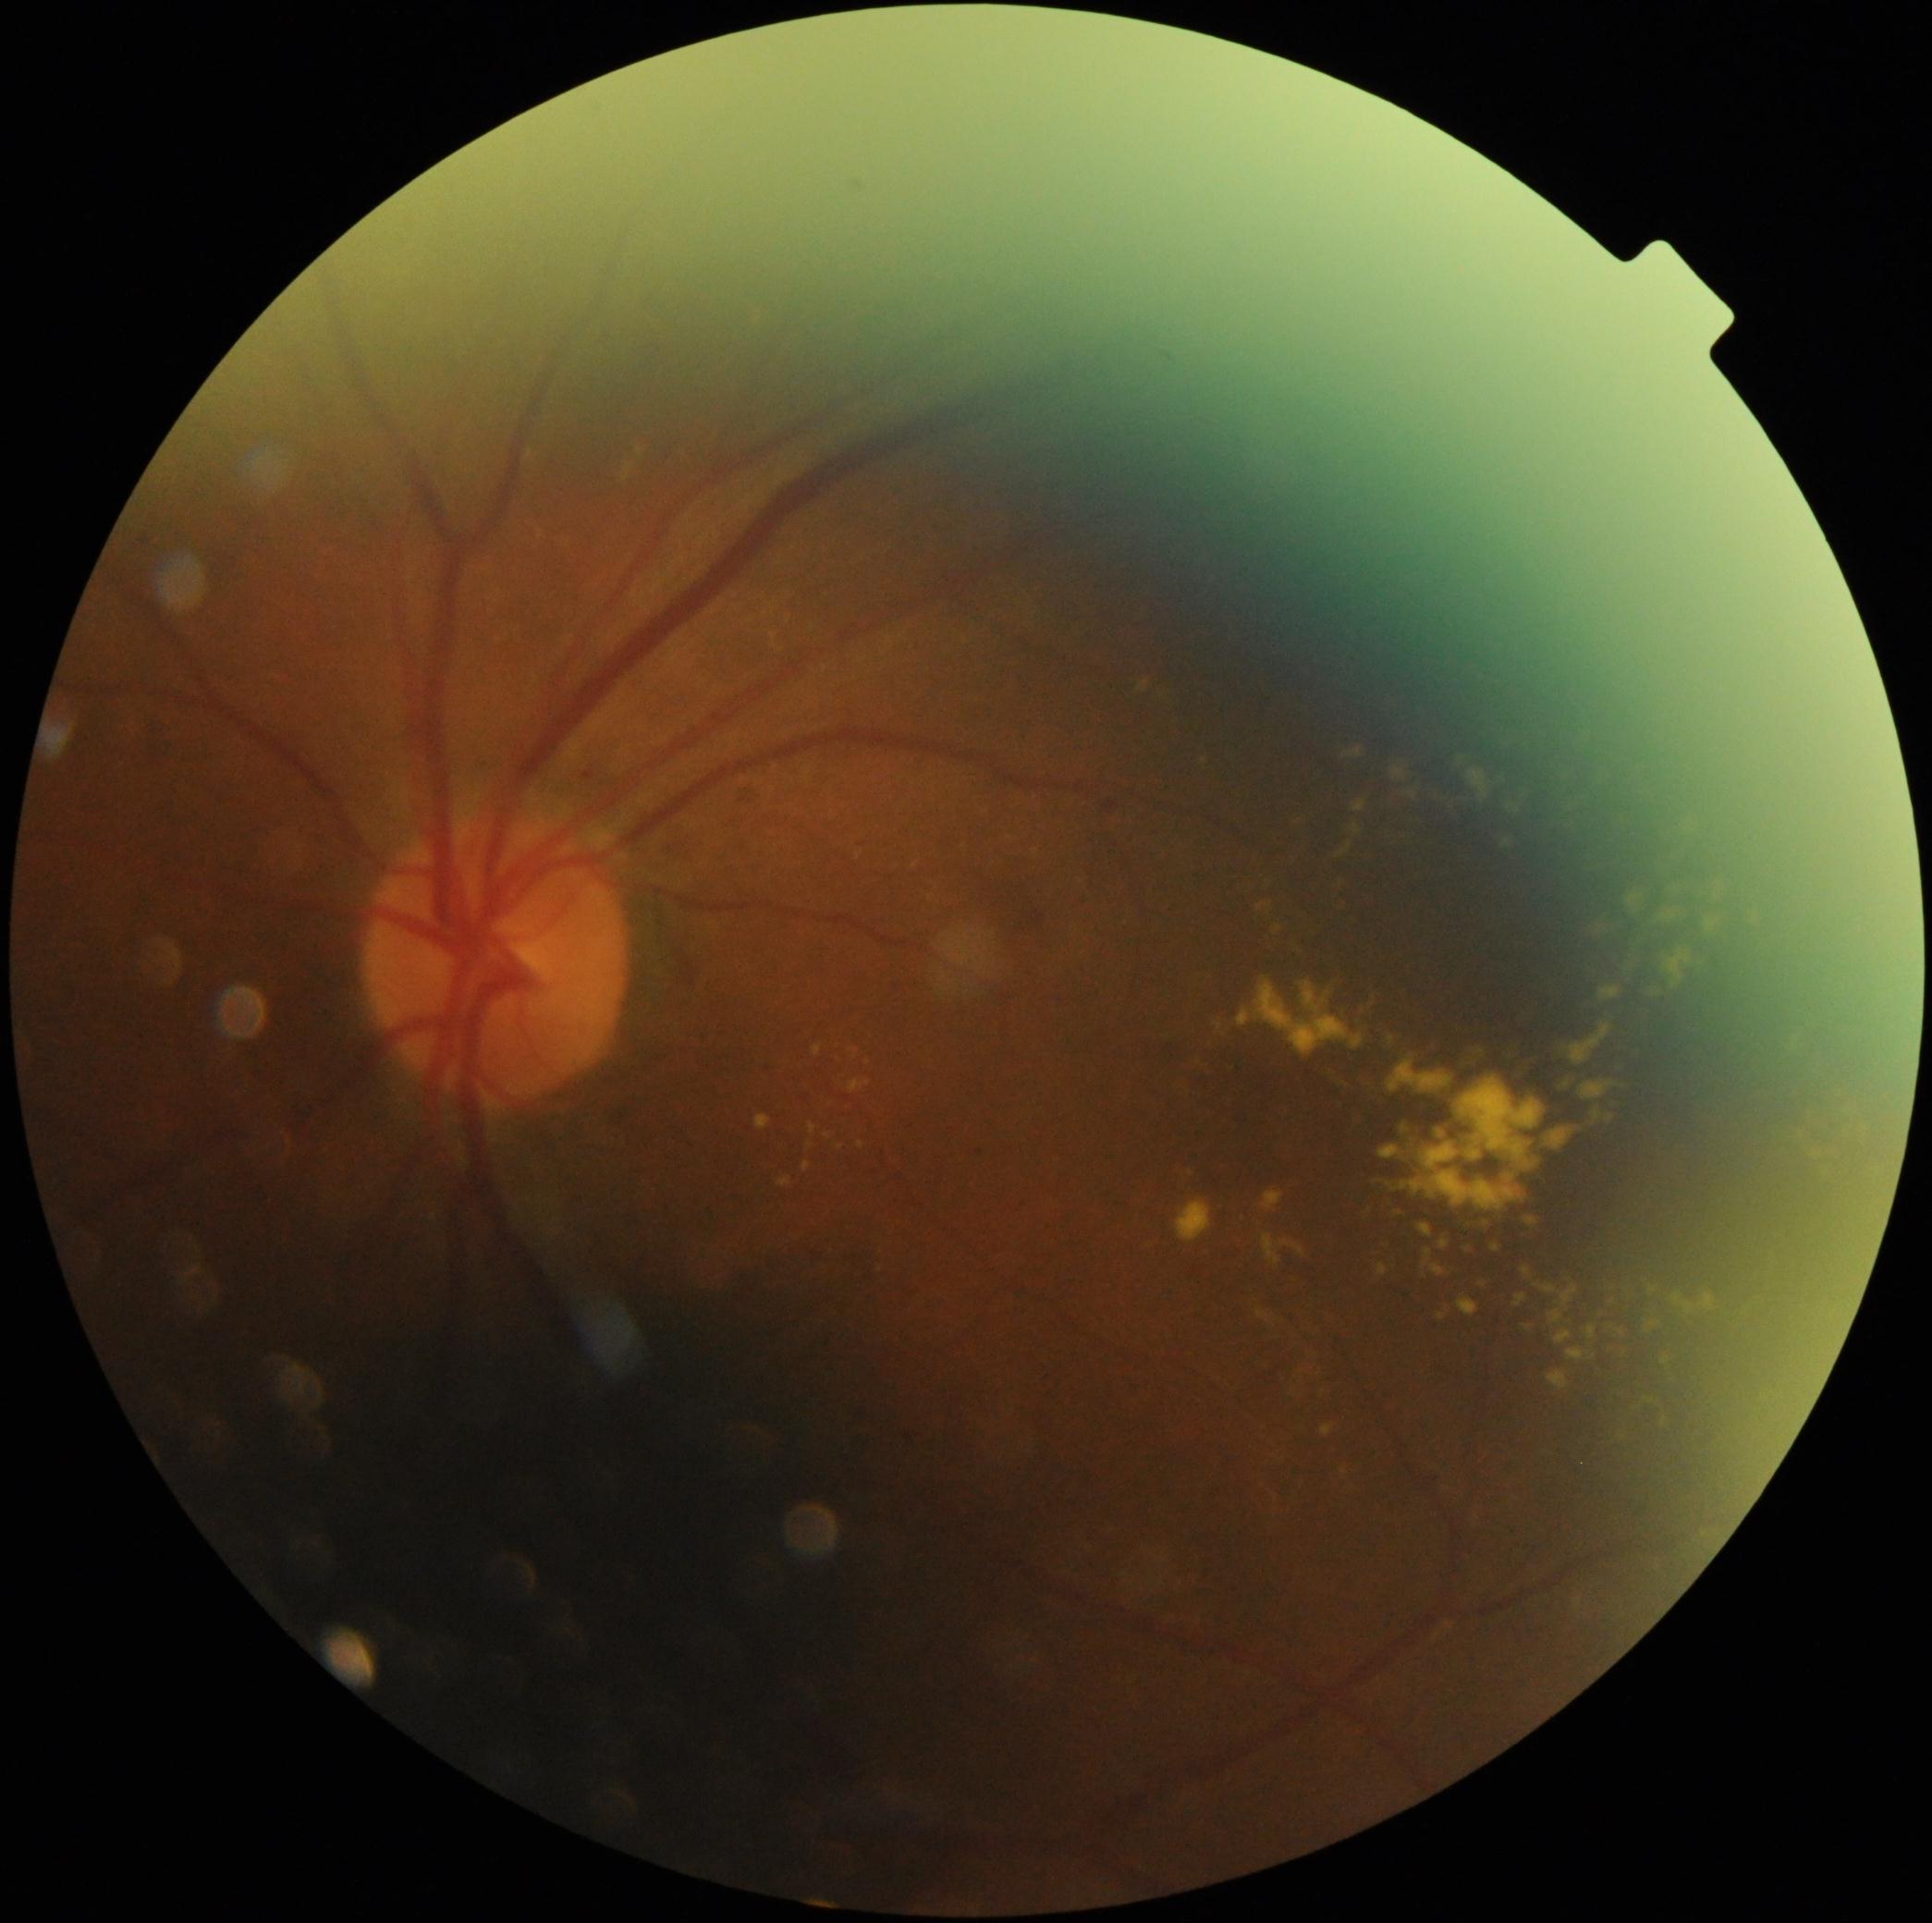
DR severity: moderate NPDR (grade 2) | DR class: non-proliferative diabetic retinopathy.